Color fundus image
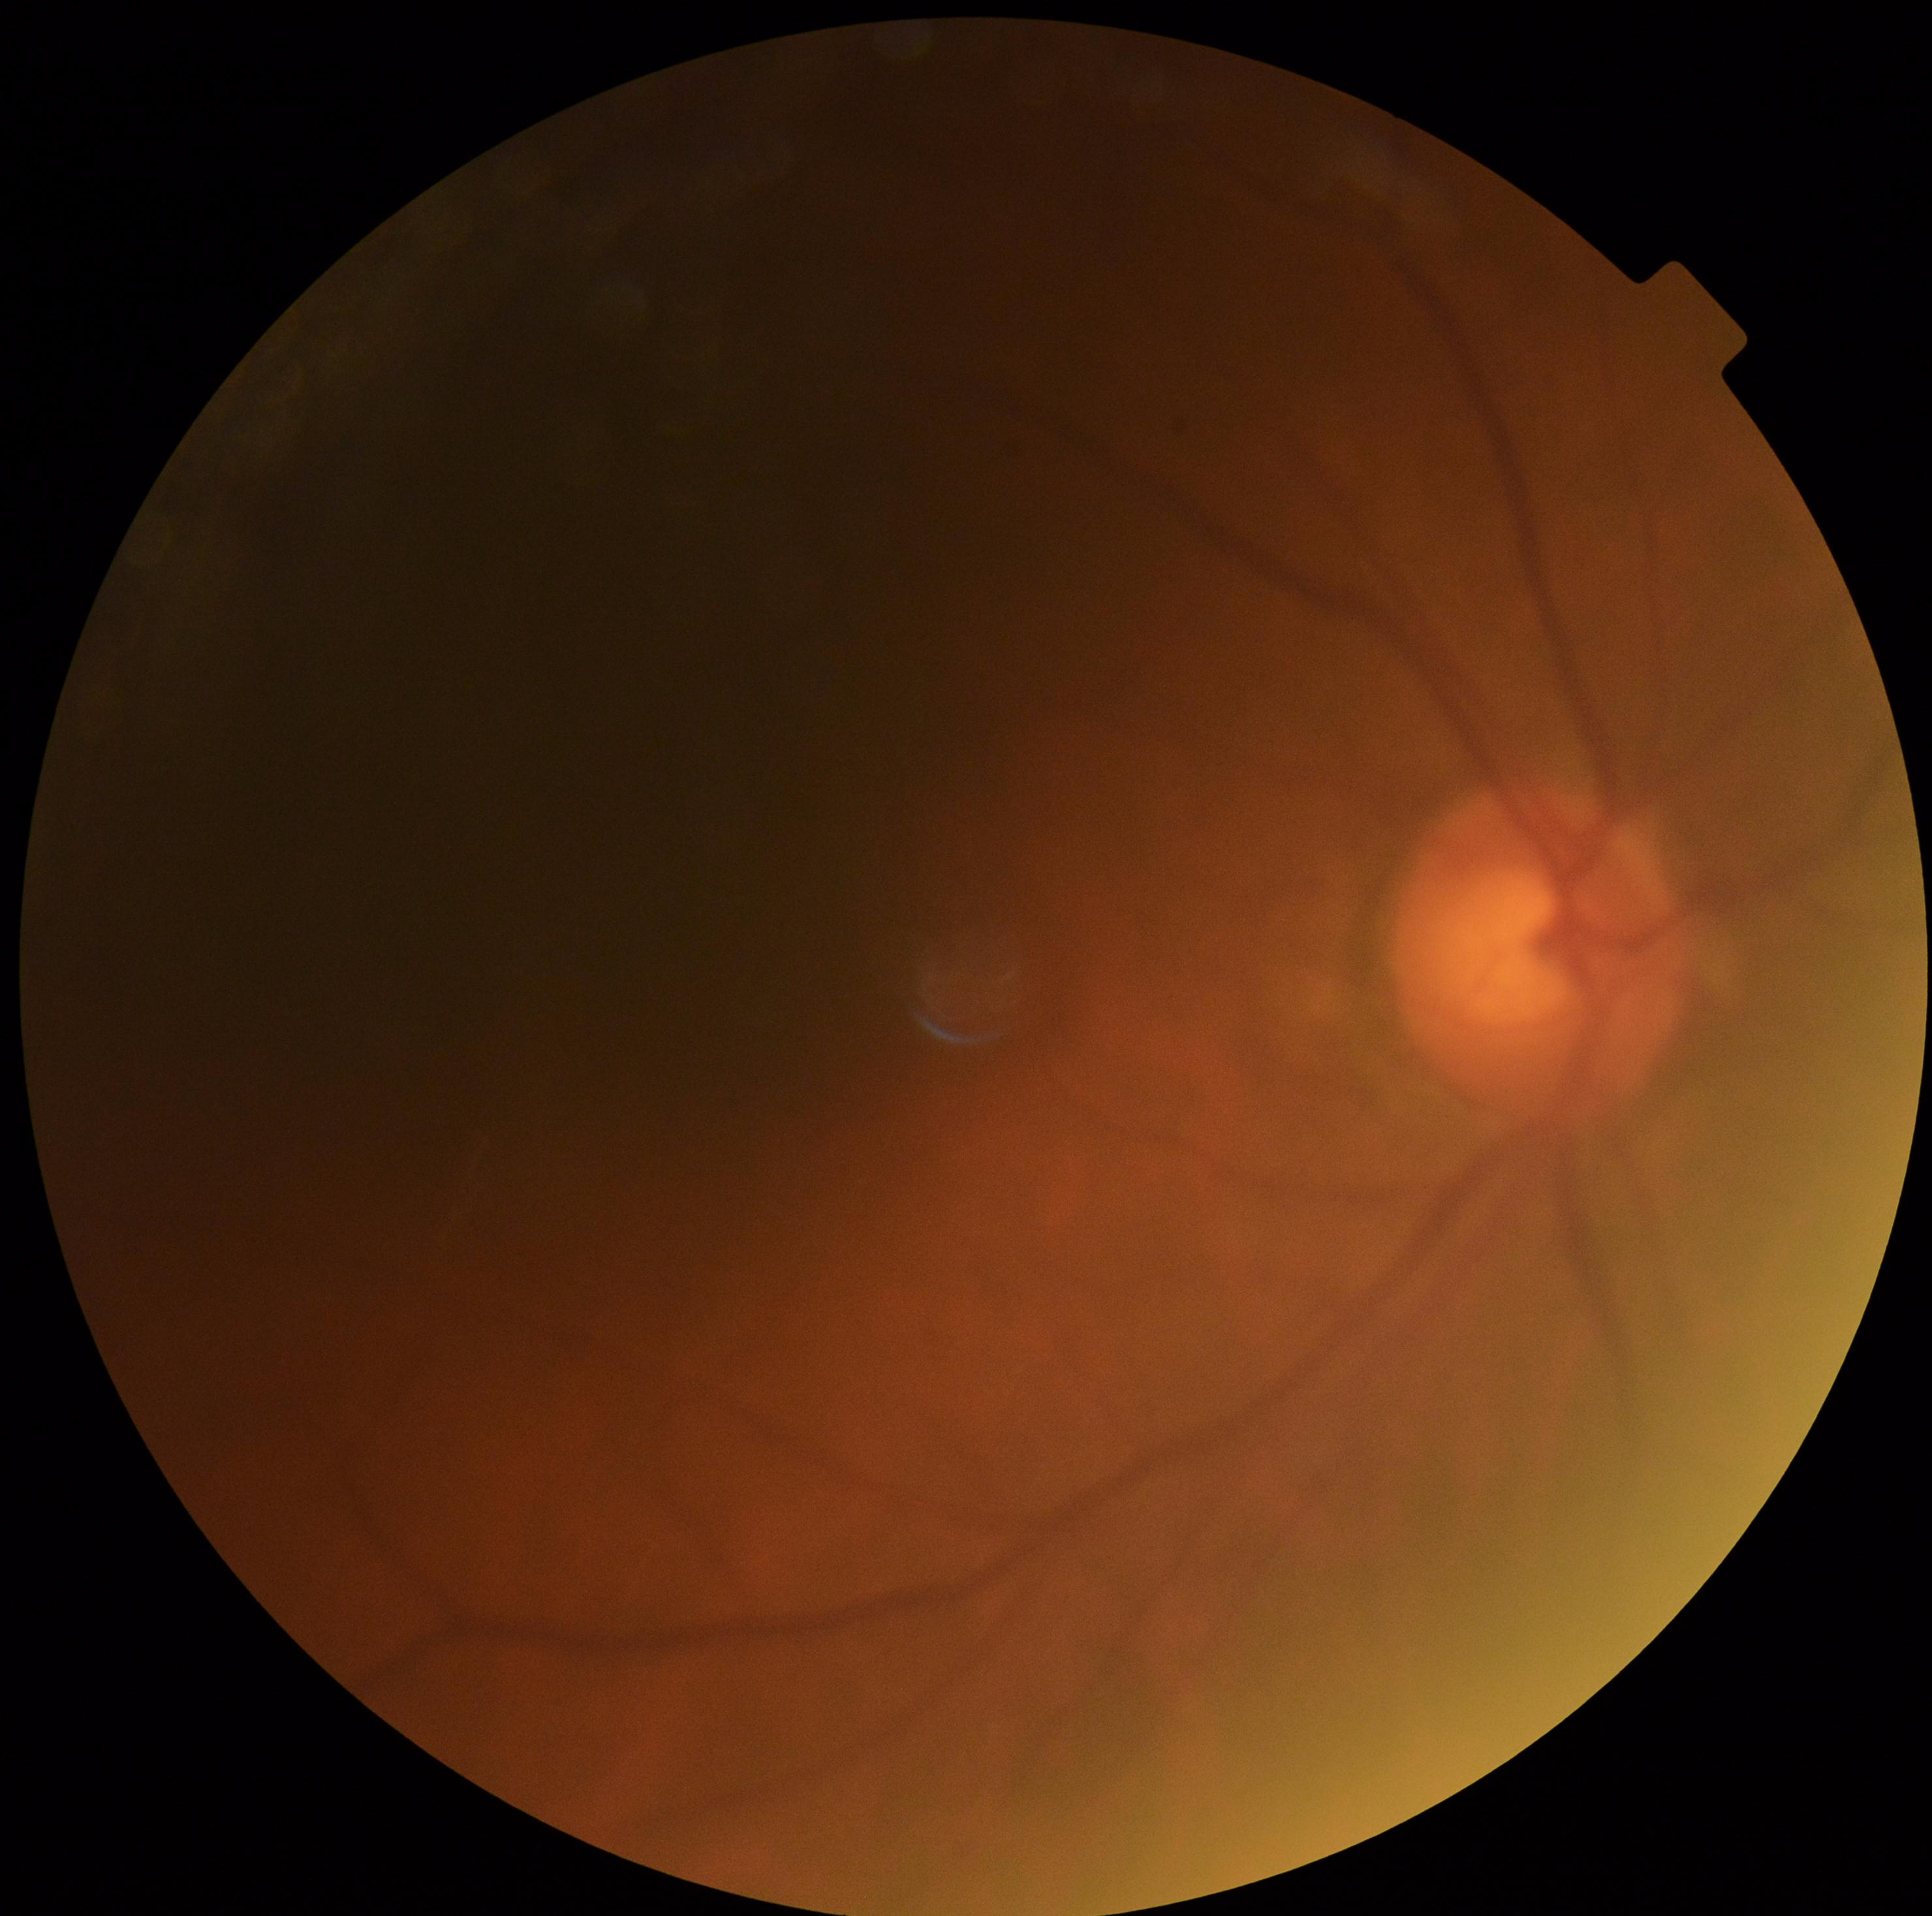
diabetic retinopathy grade=ungradable due to poor image quality, image quality=insufficient for DR assessment.